Infant wide-field retinal image:
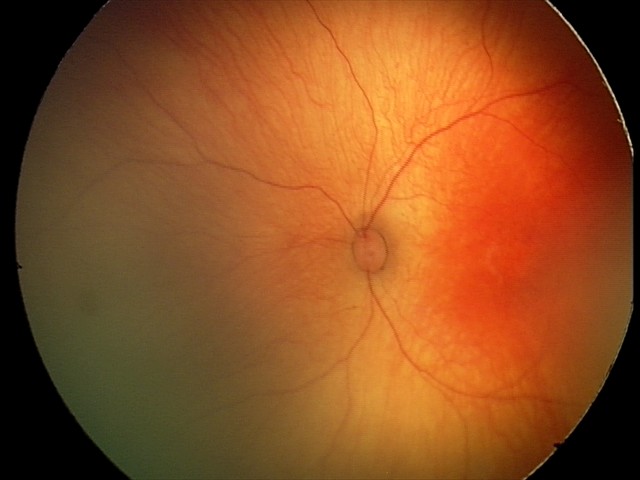
Q: What is the diagnosis from this examination?
A: physiological retinal finding